2212x1659px, 45° FOV, fundus photo:
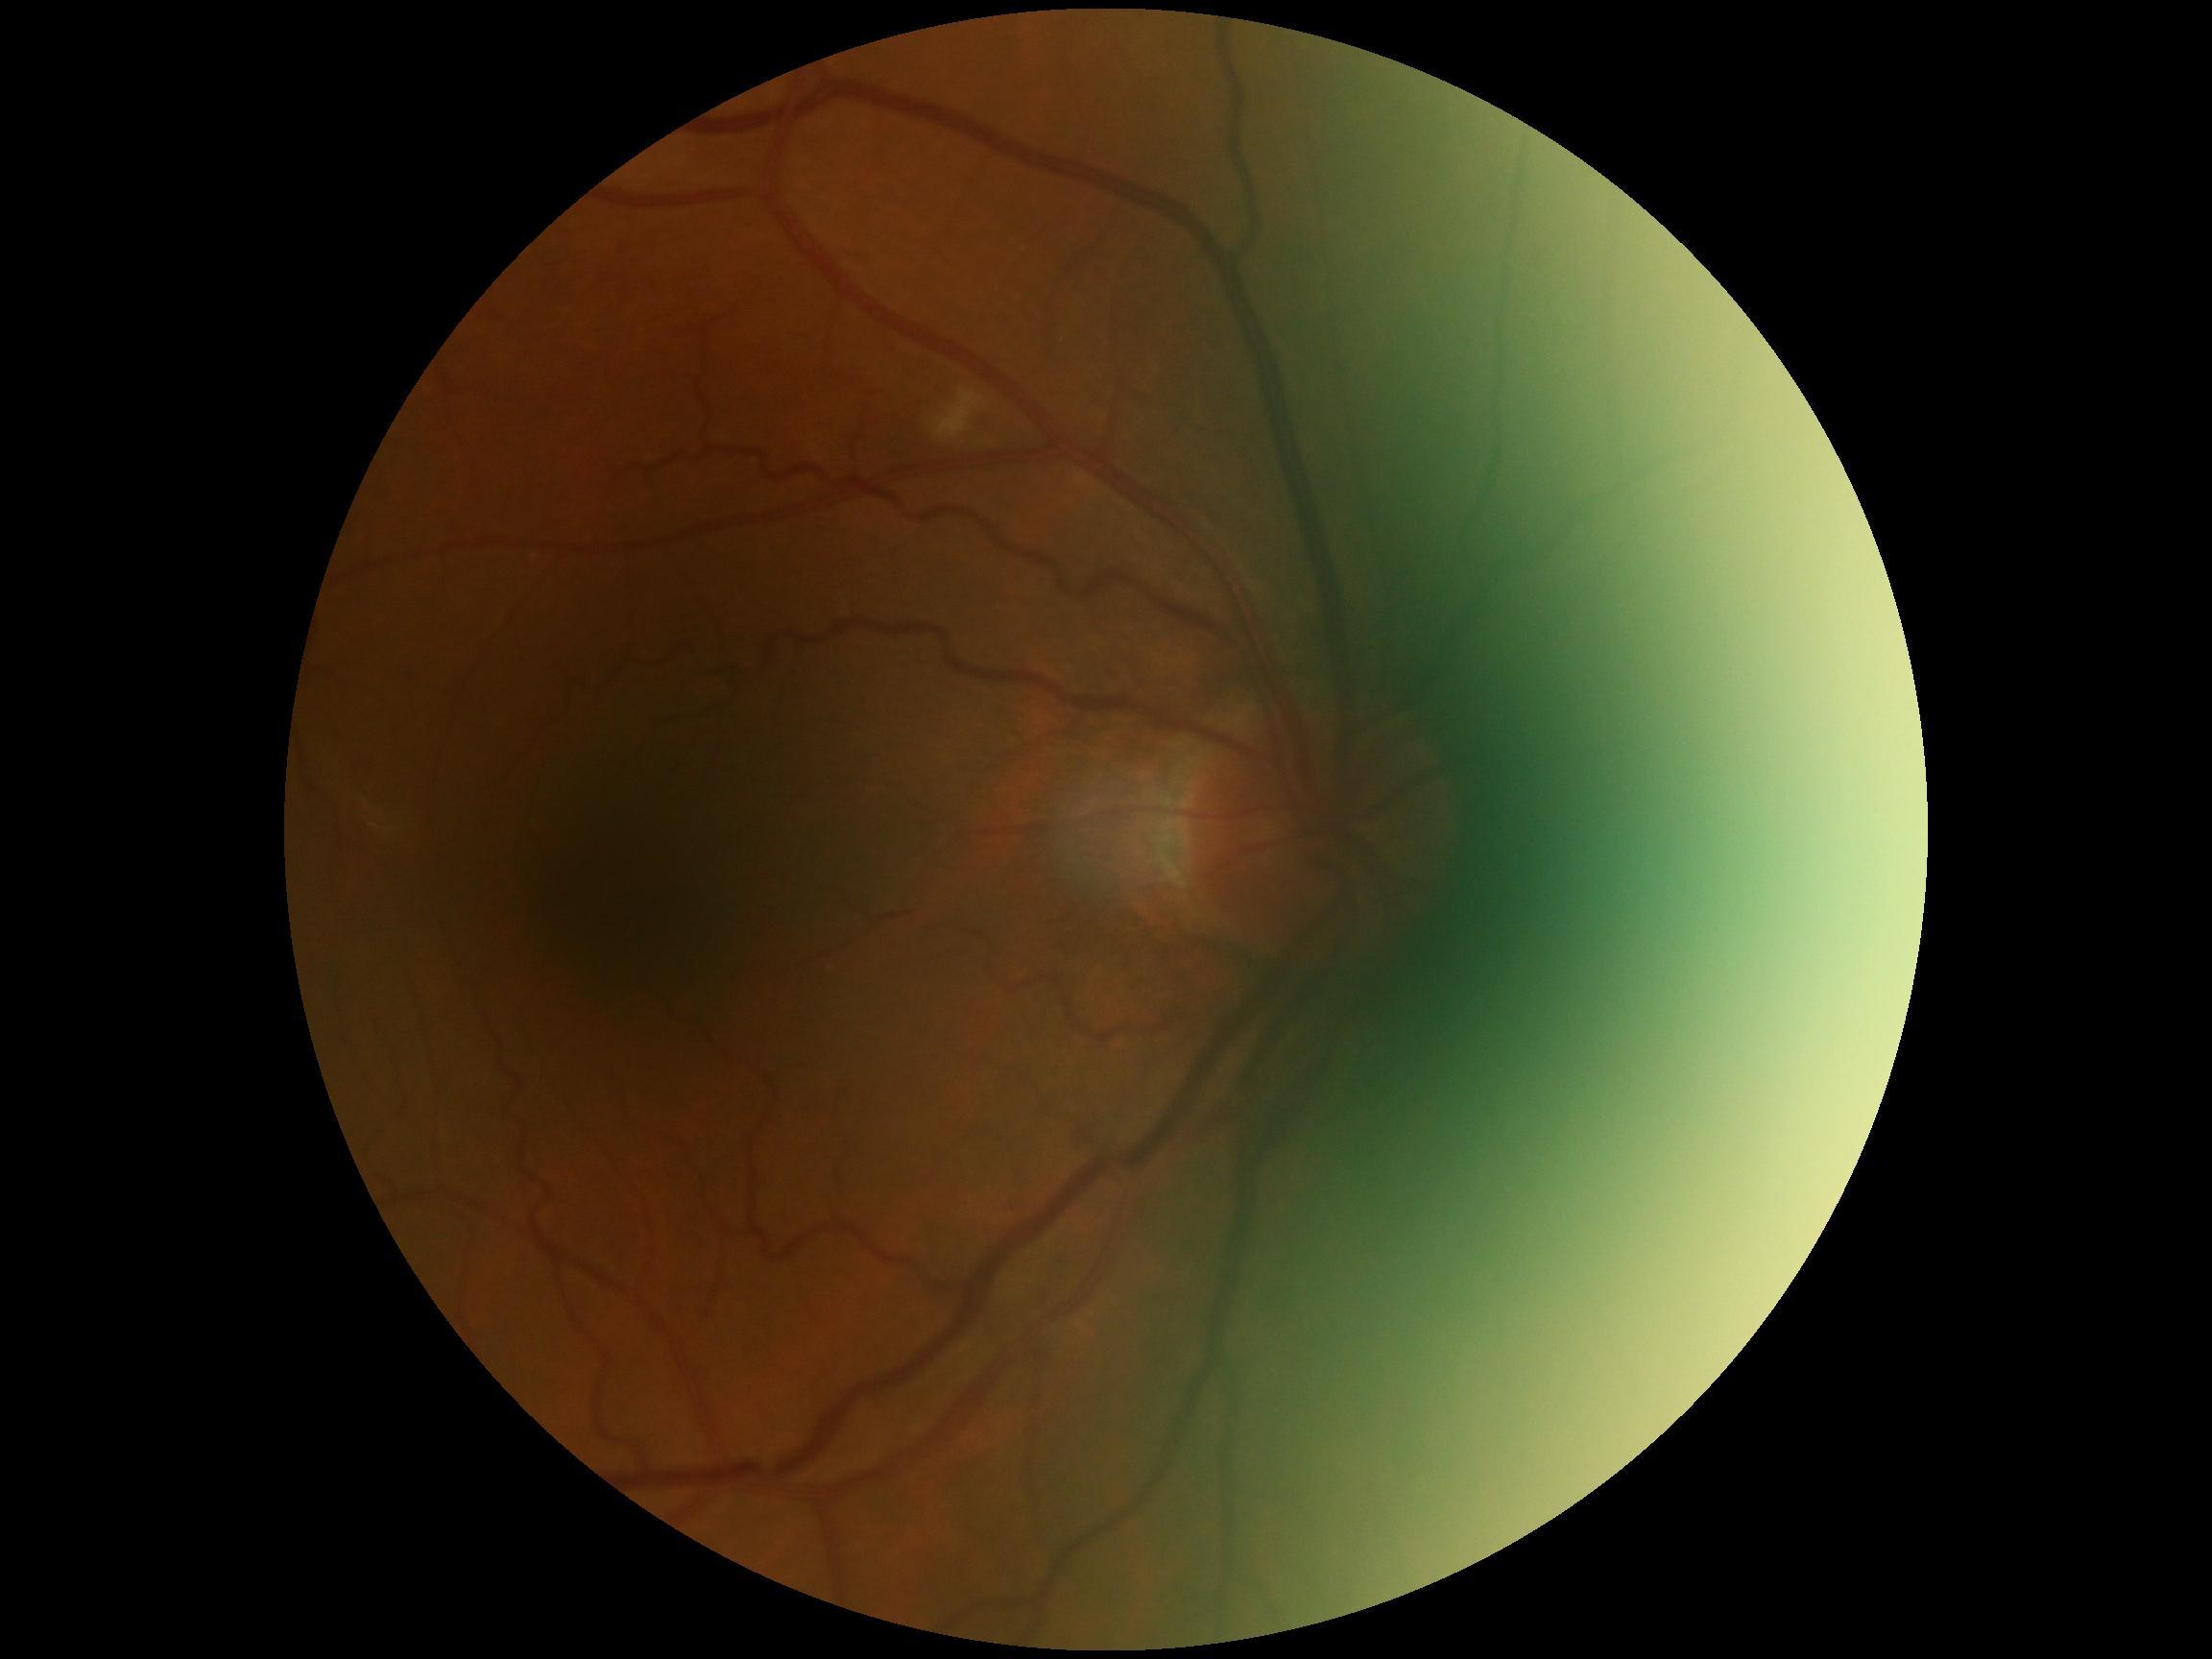

DR grade: 2.